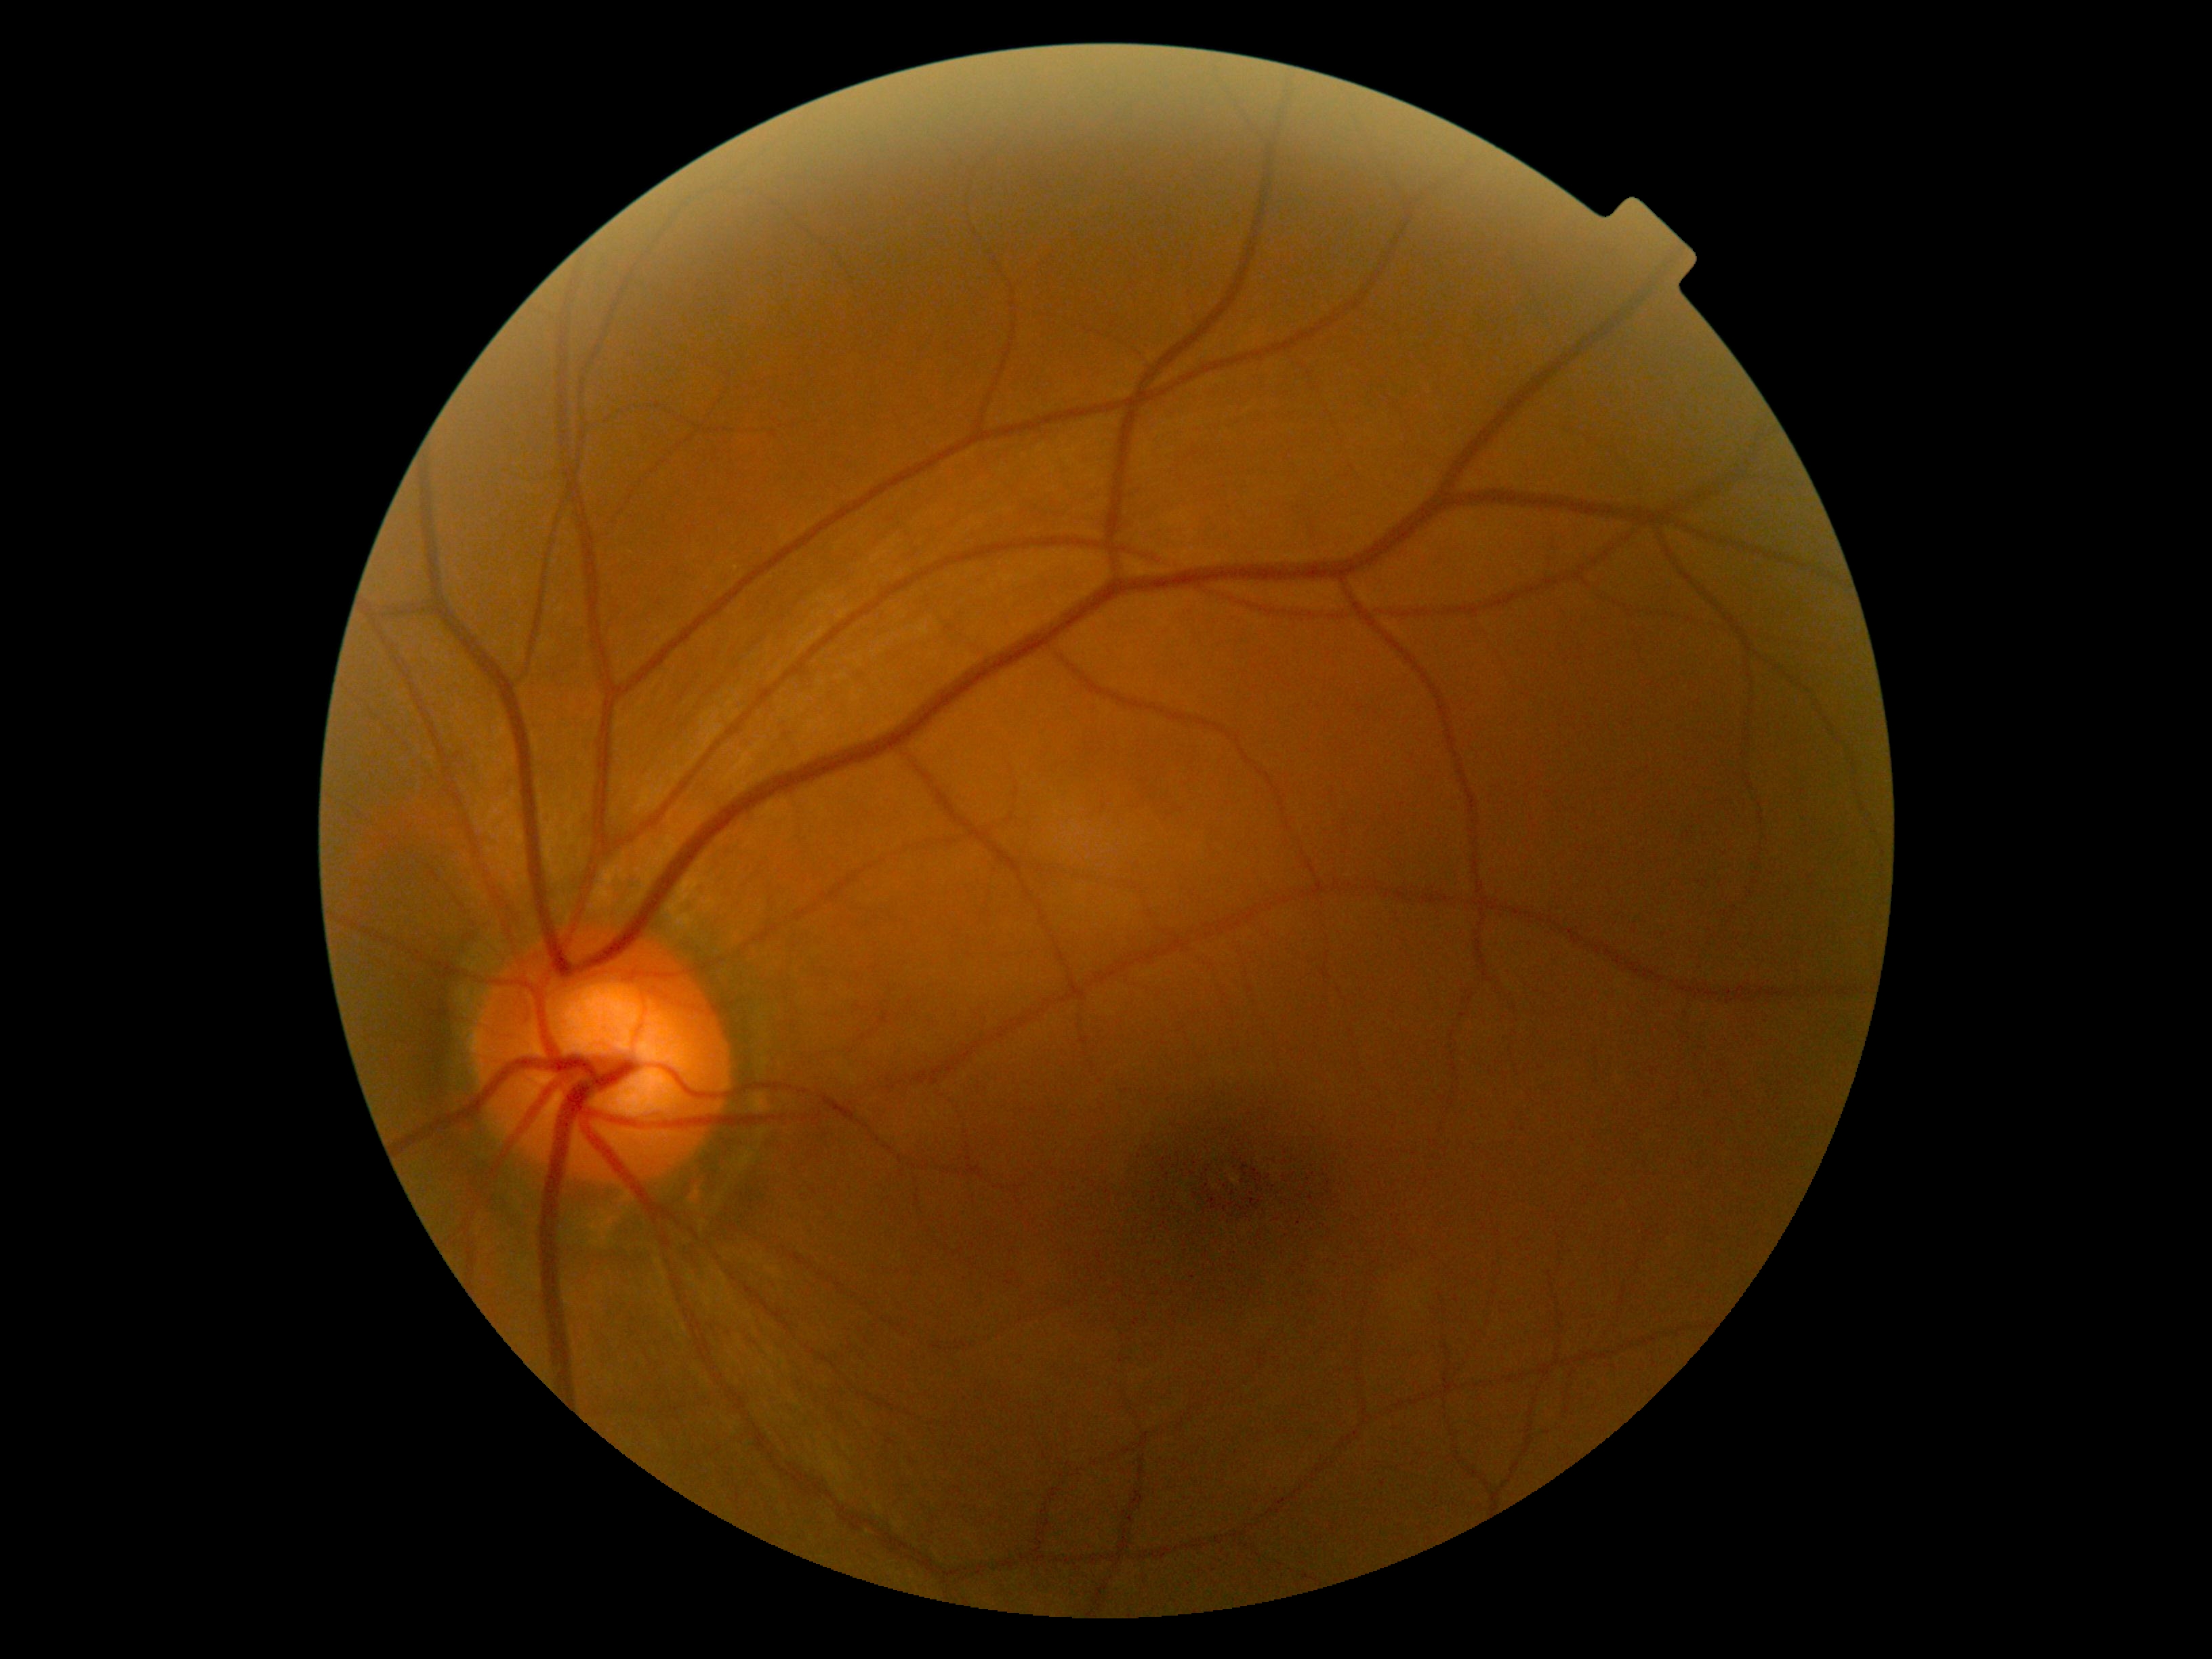
diabetic retinopathy severity: grade 0 (no apparent retinopathy)